Posterior pole field covering the optic disc and macula · 2228 x 1652 pixels · camera: Topcon TRC-50DX.
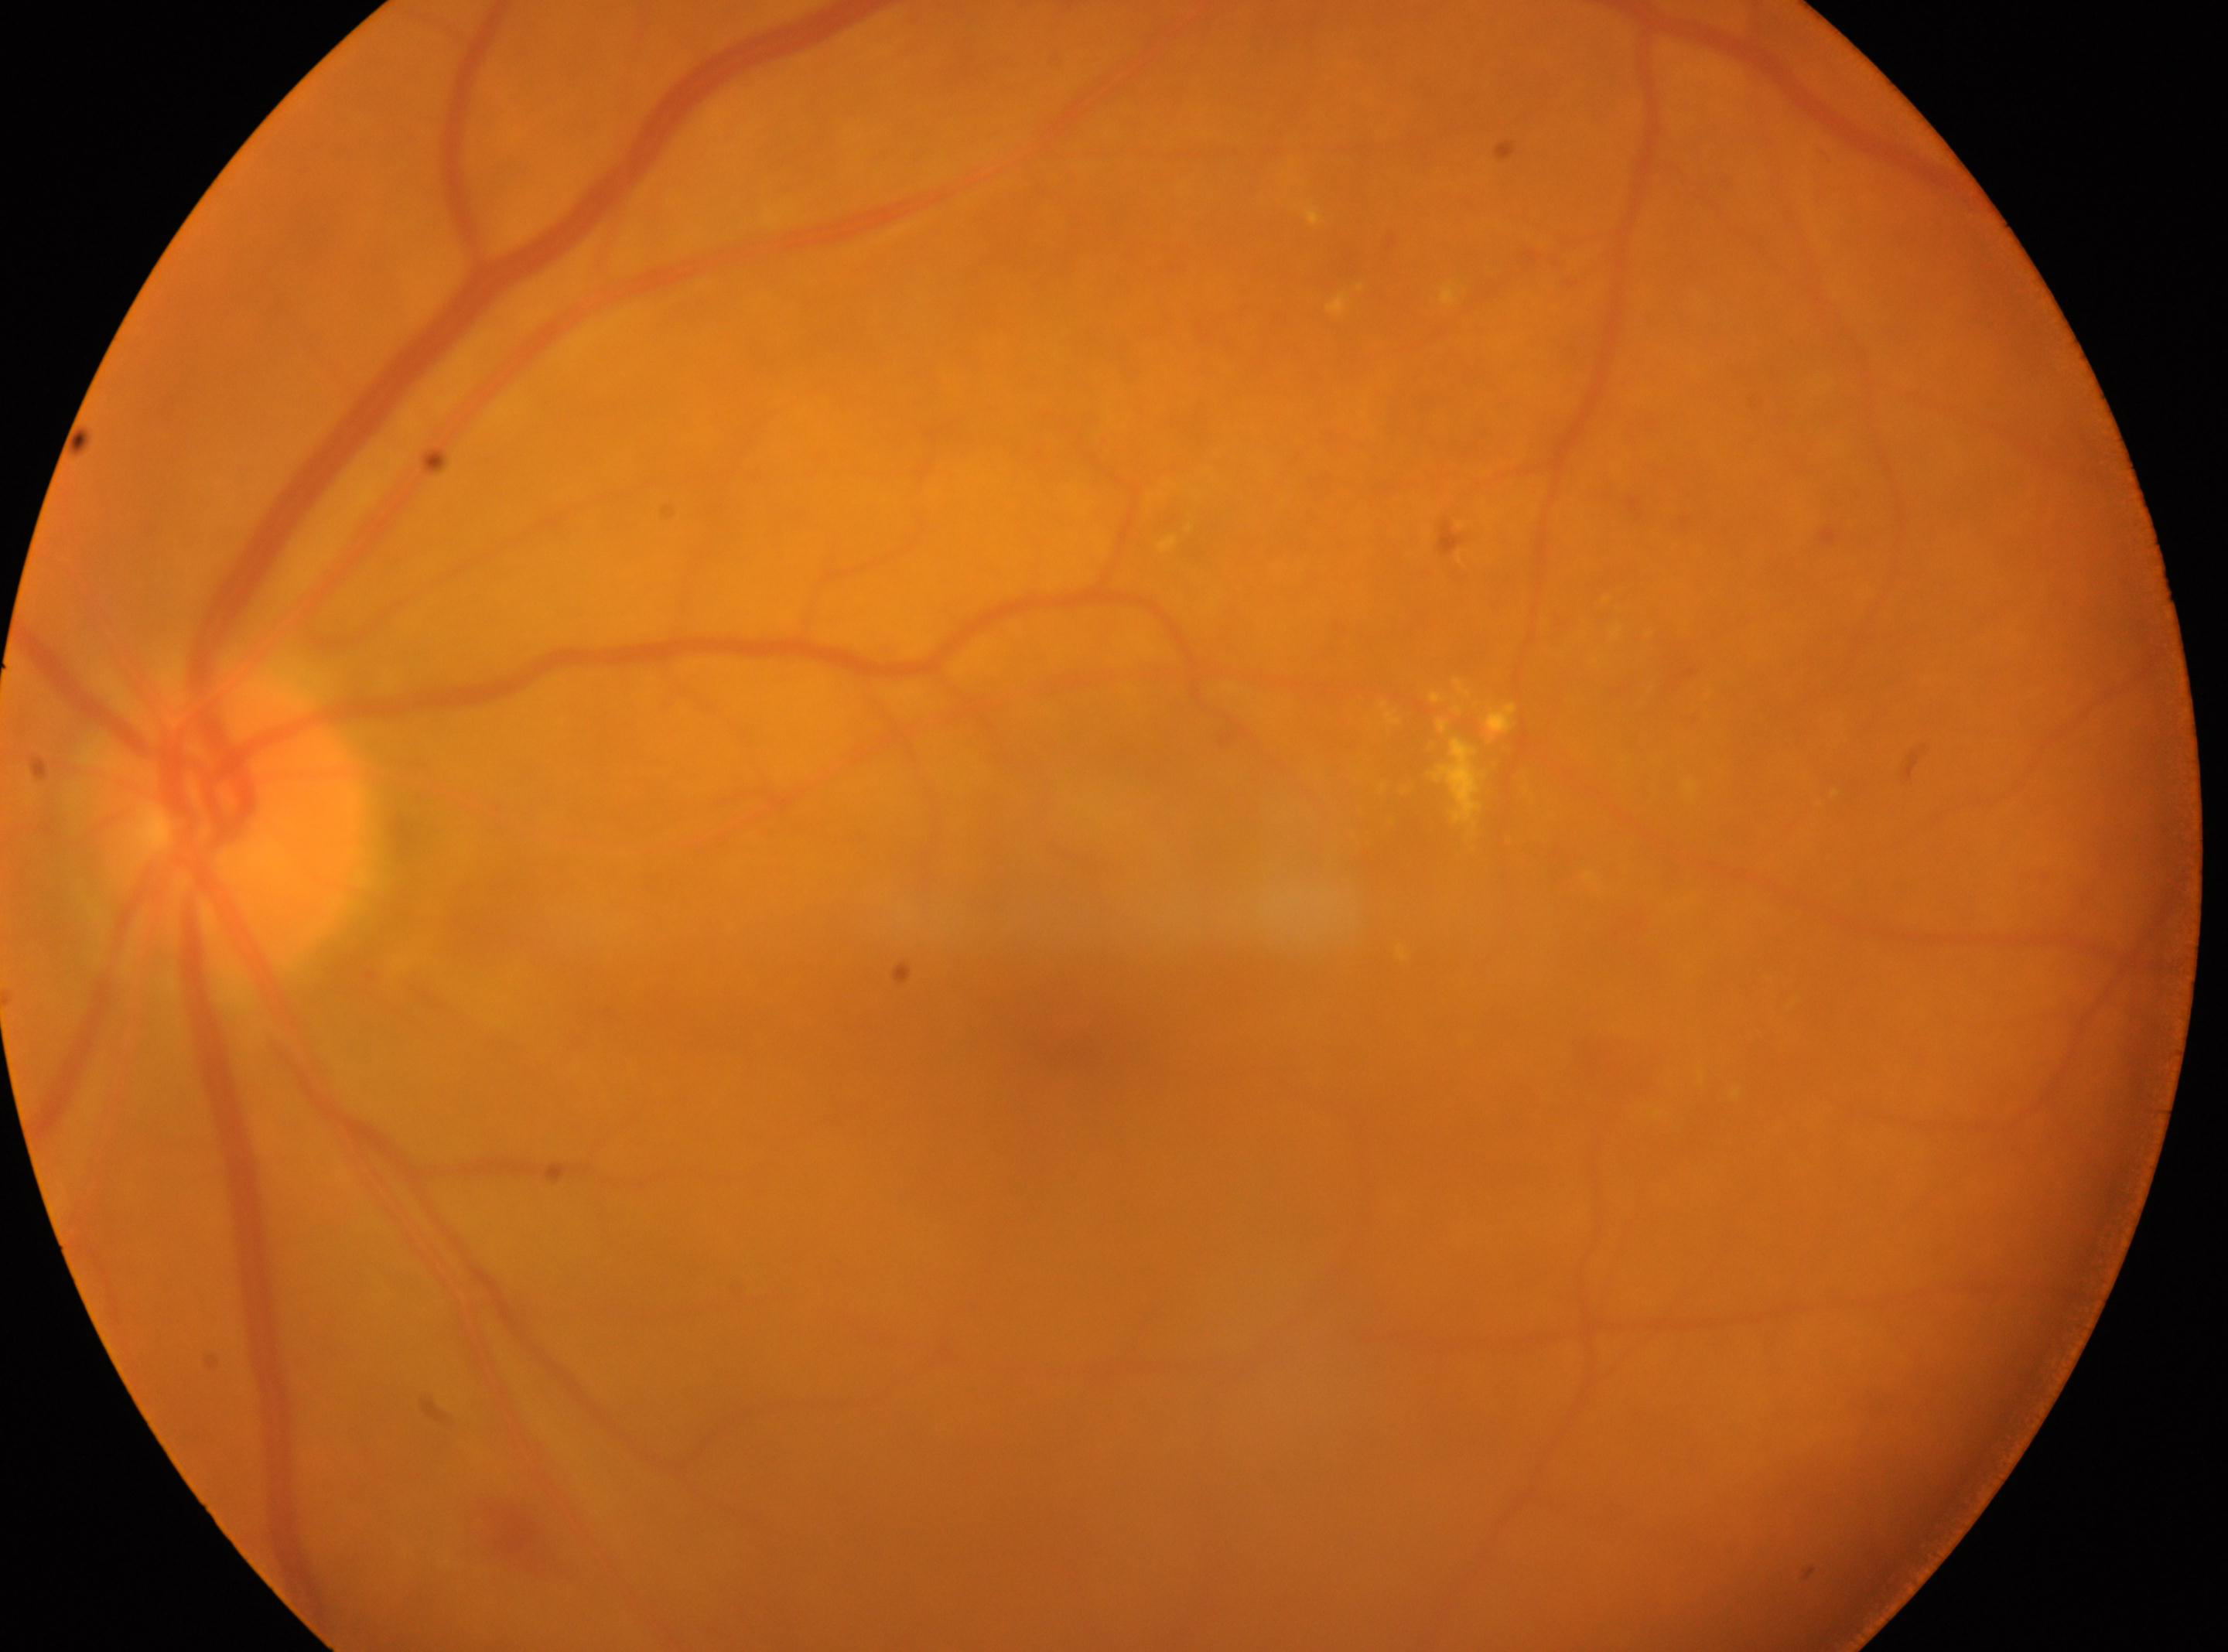

{"dr_category": "non-proliferative diabetic retinopathy", "eye": "oculus sinister", "optic_disc": "(224,821)", "fovea": "(1071,1029)", "dr_grade": "2/4 — more than just microaneurysms but less than severe NPDR"}